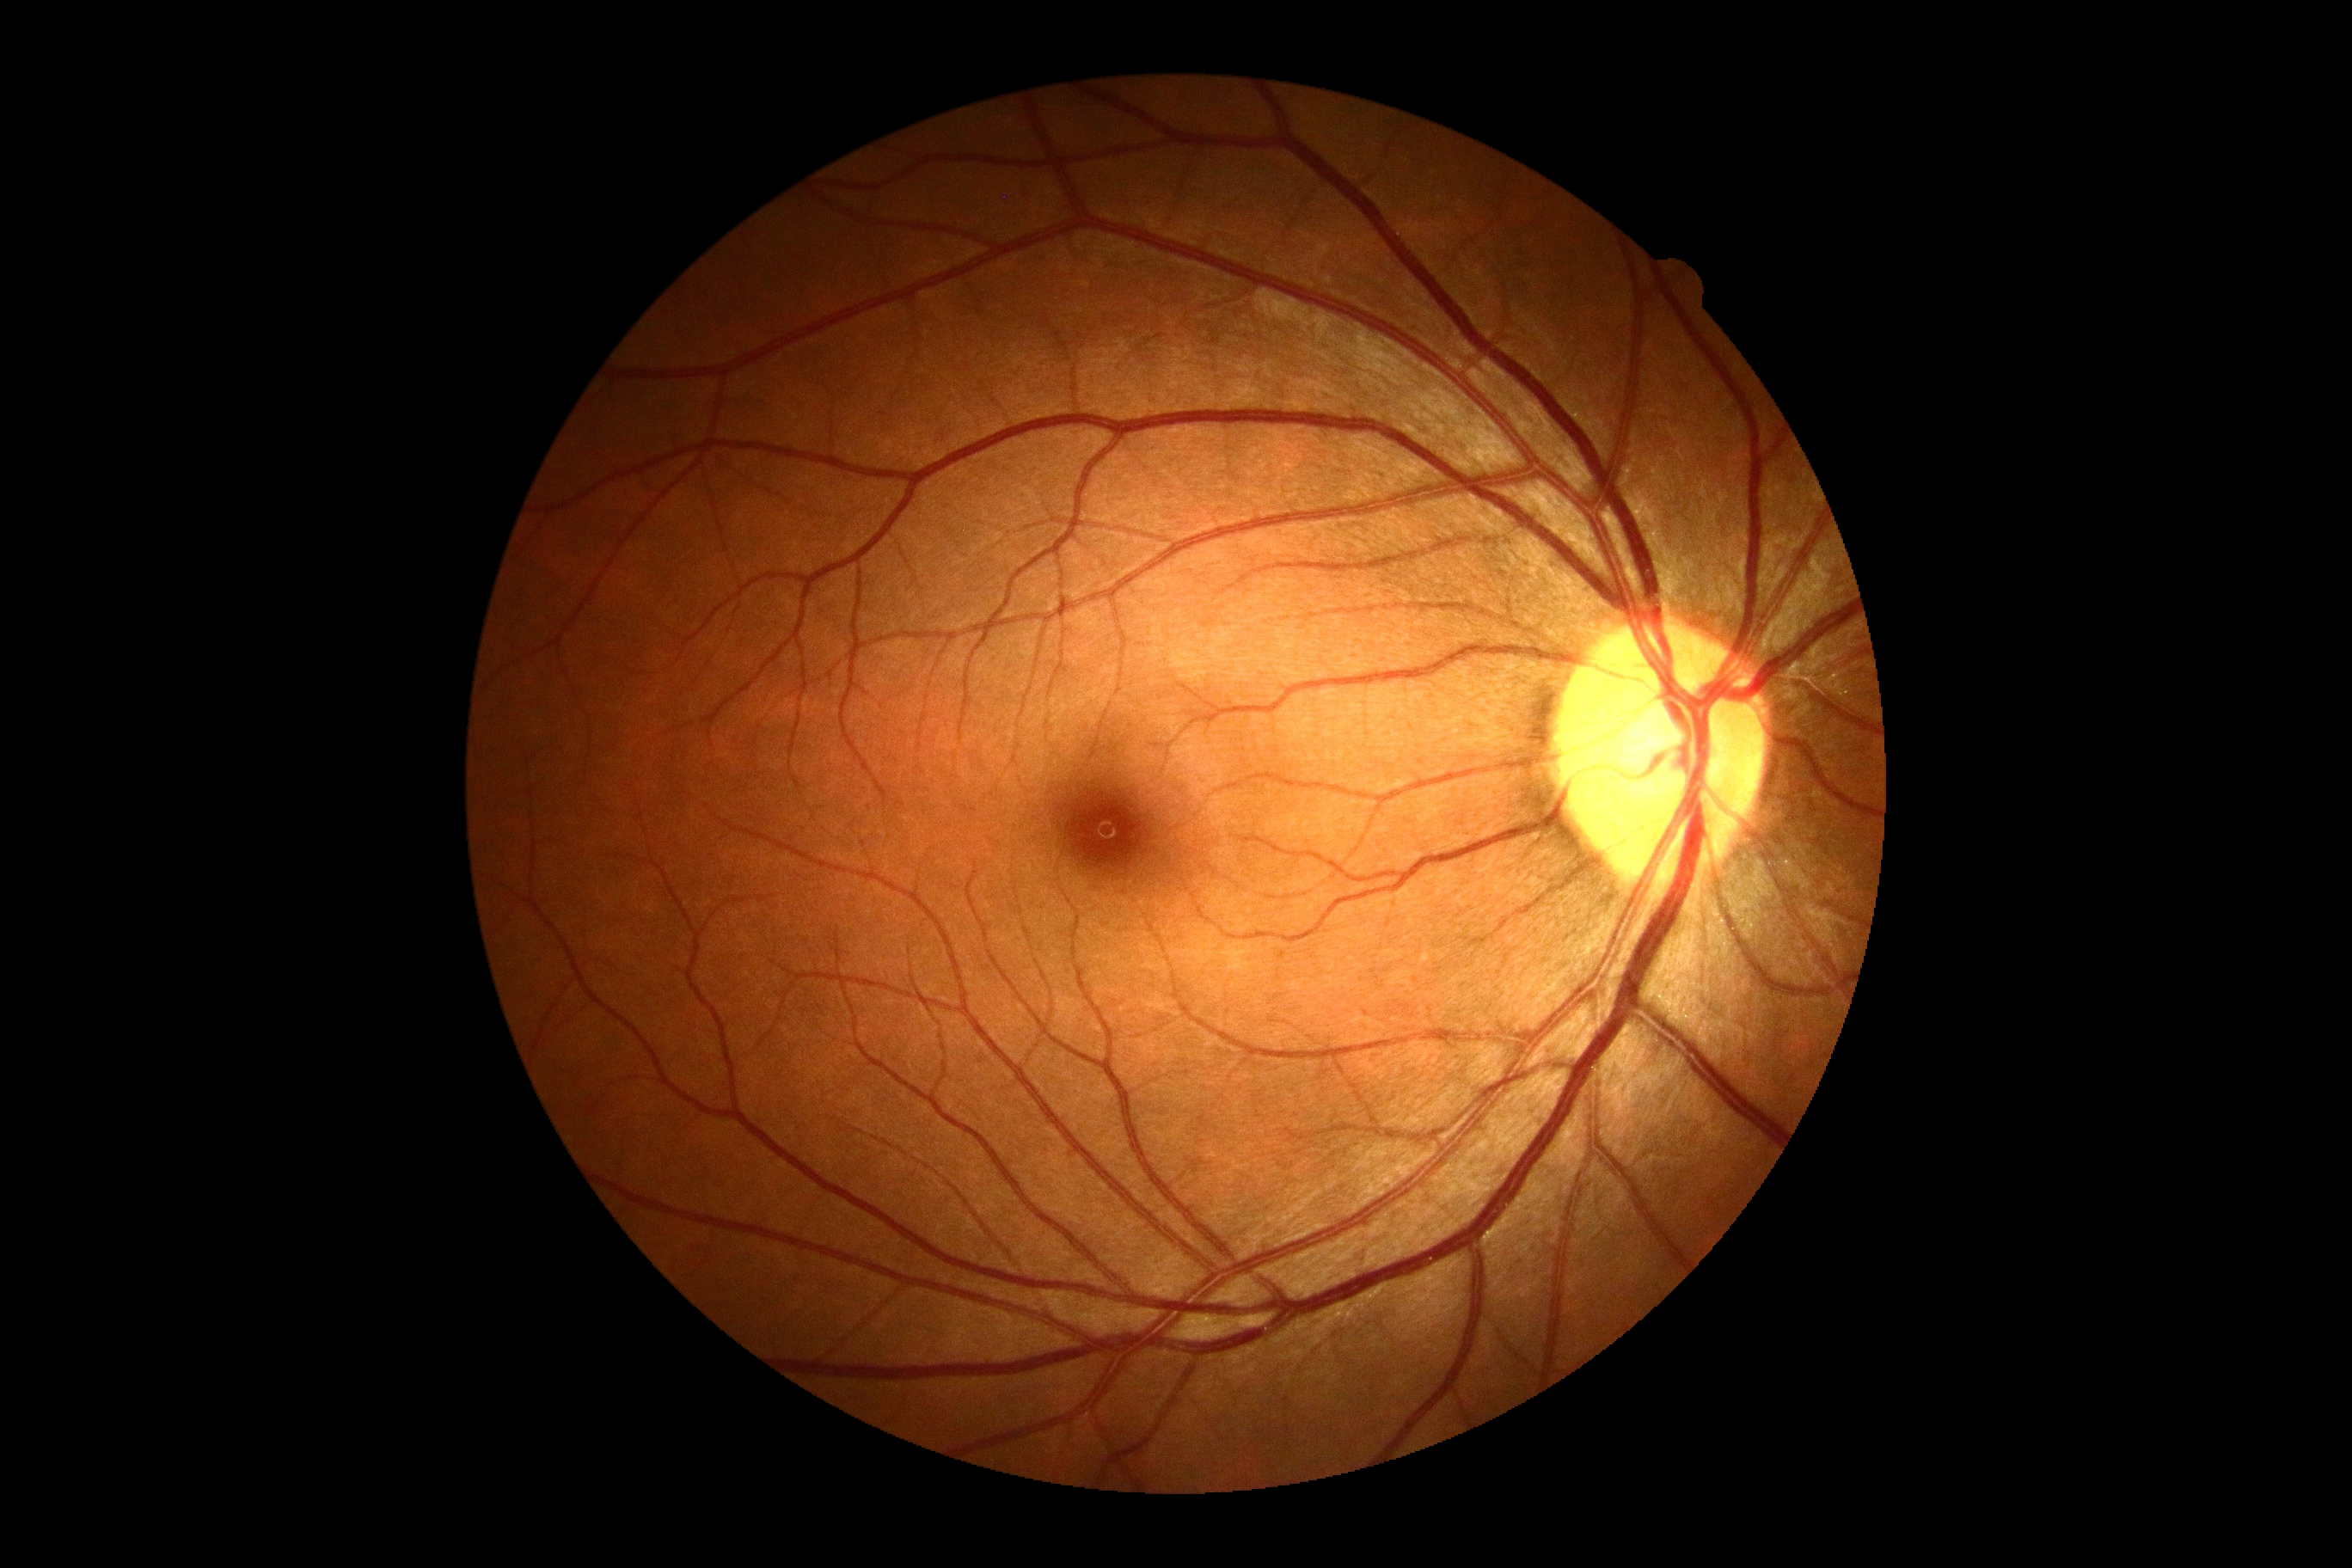
Diabetic retinopathy (DR): grade 0.